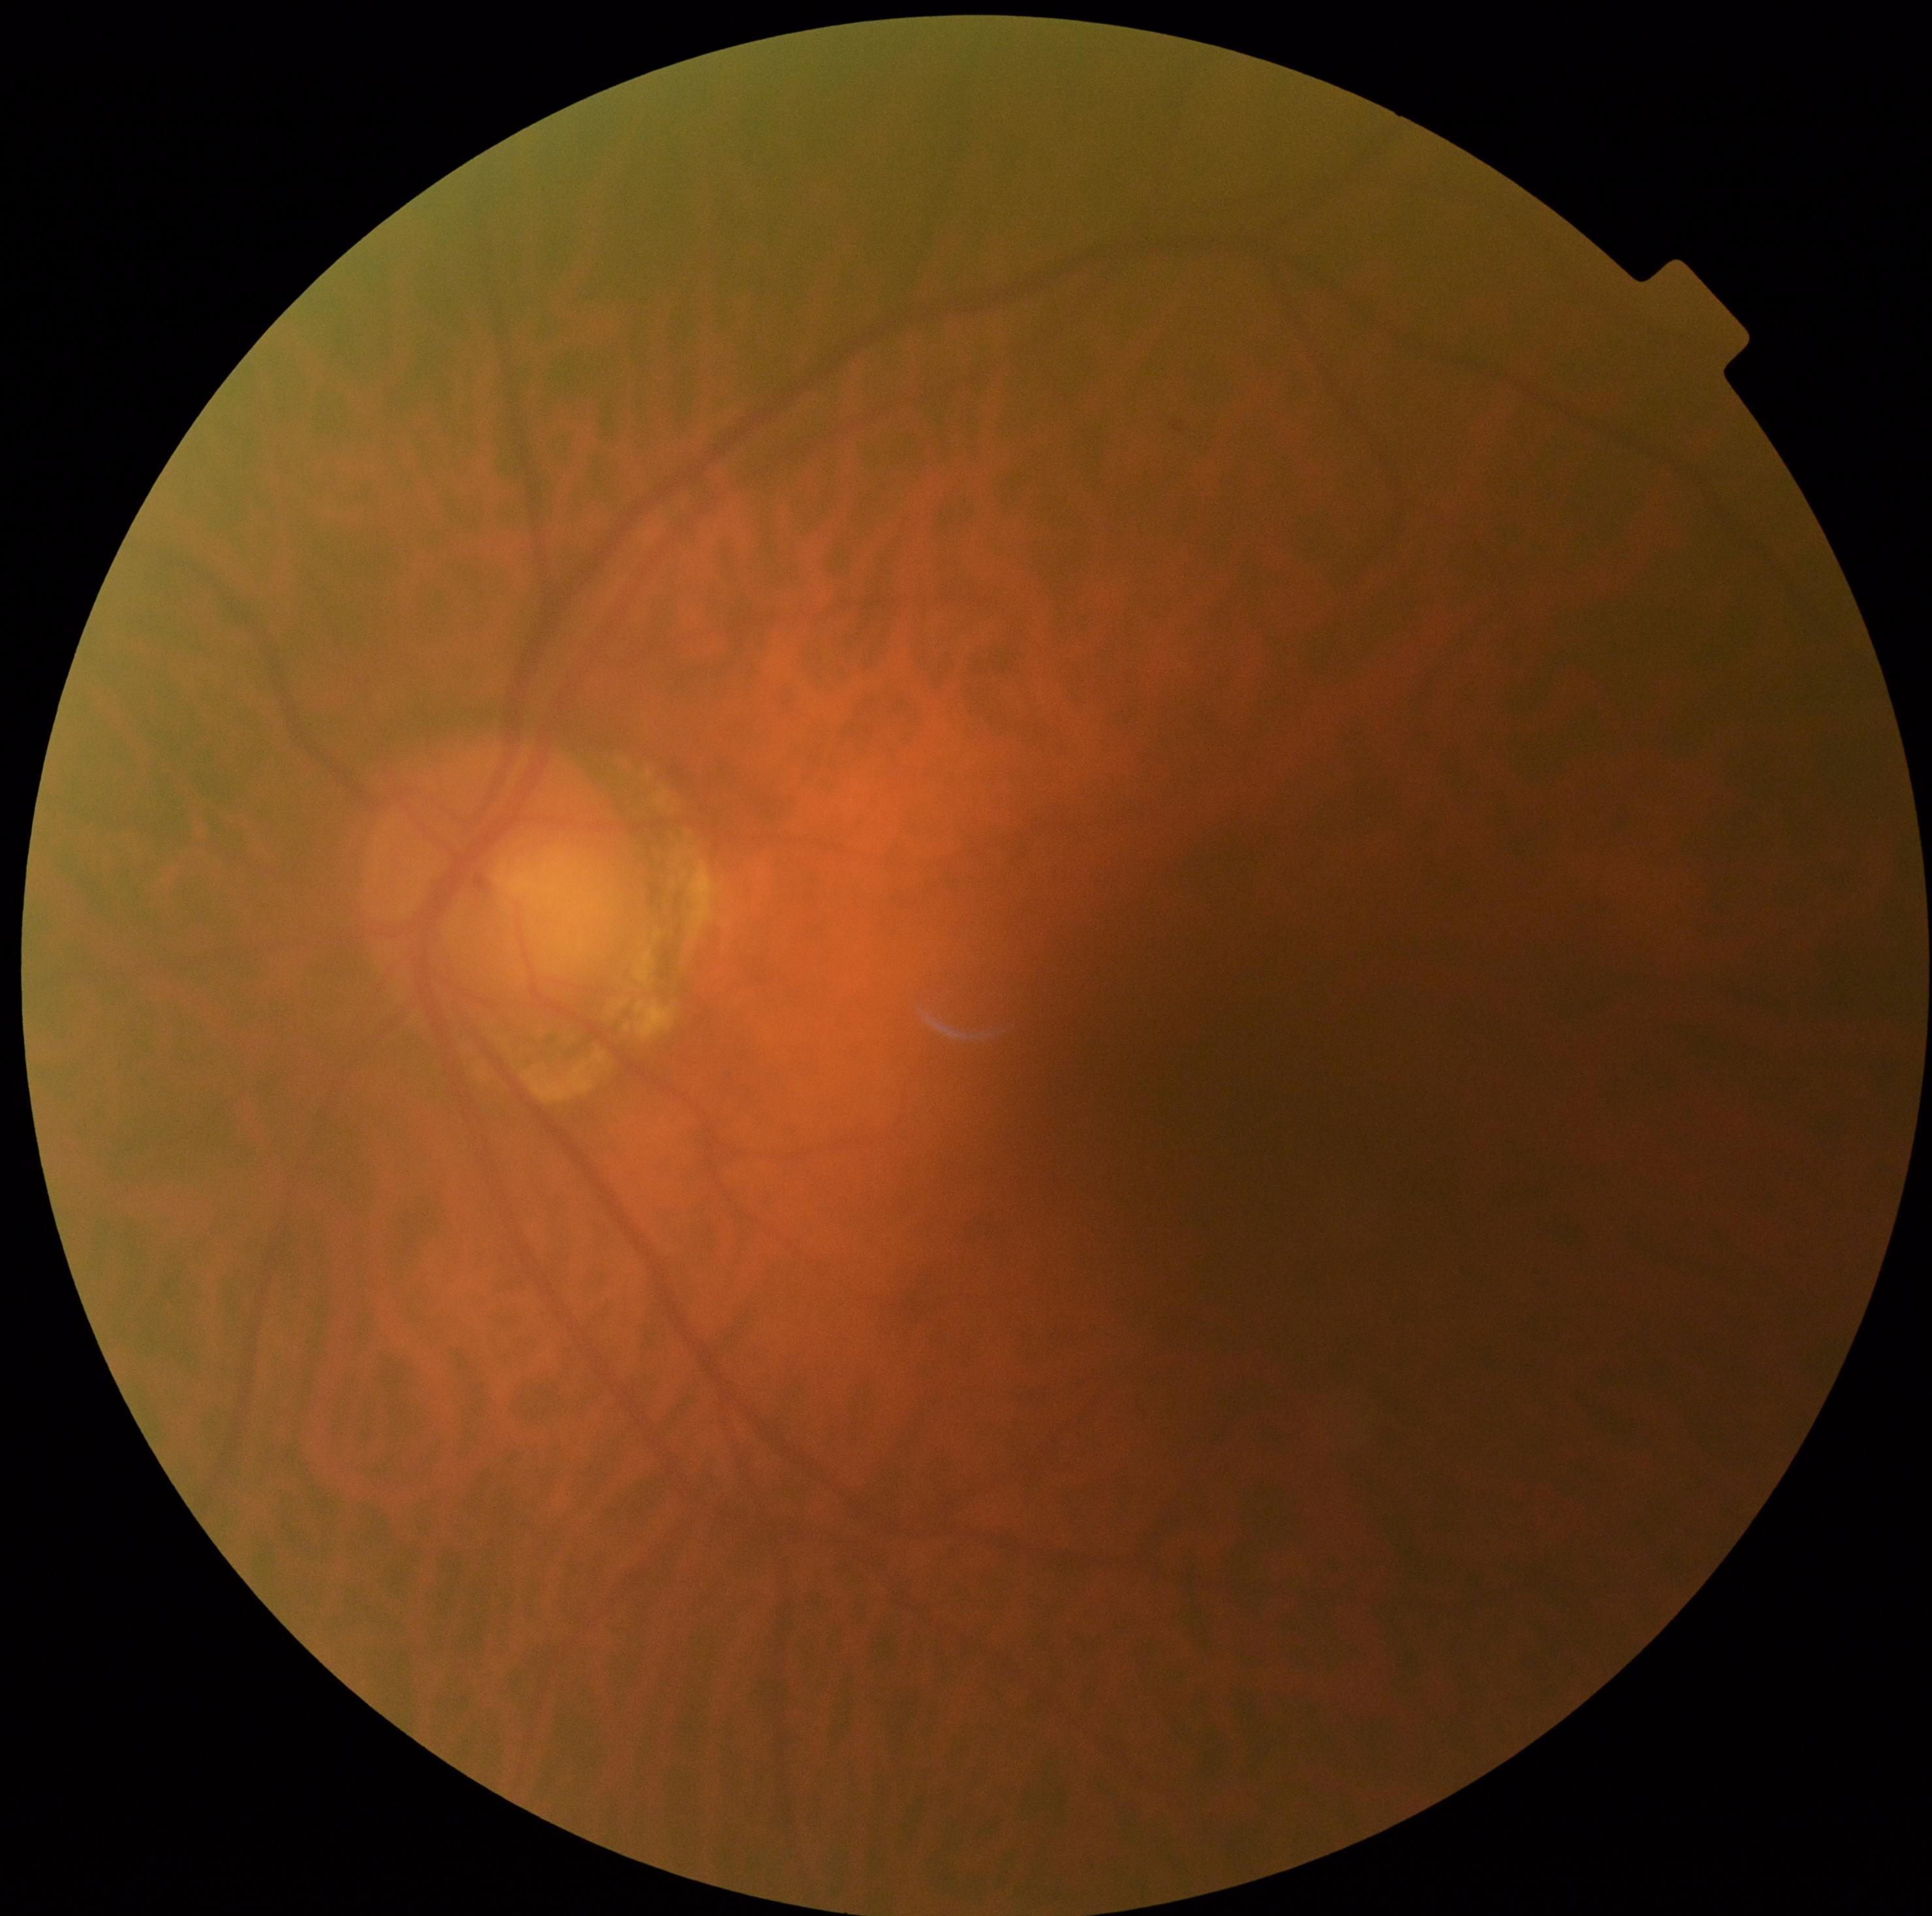   dr_grade: grade 0 (no apparent retinopathy)